Retinal fundus photograph, 45° field of view
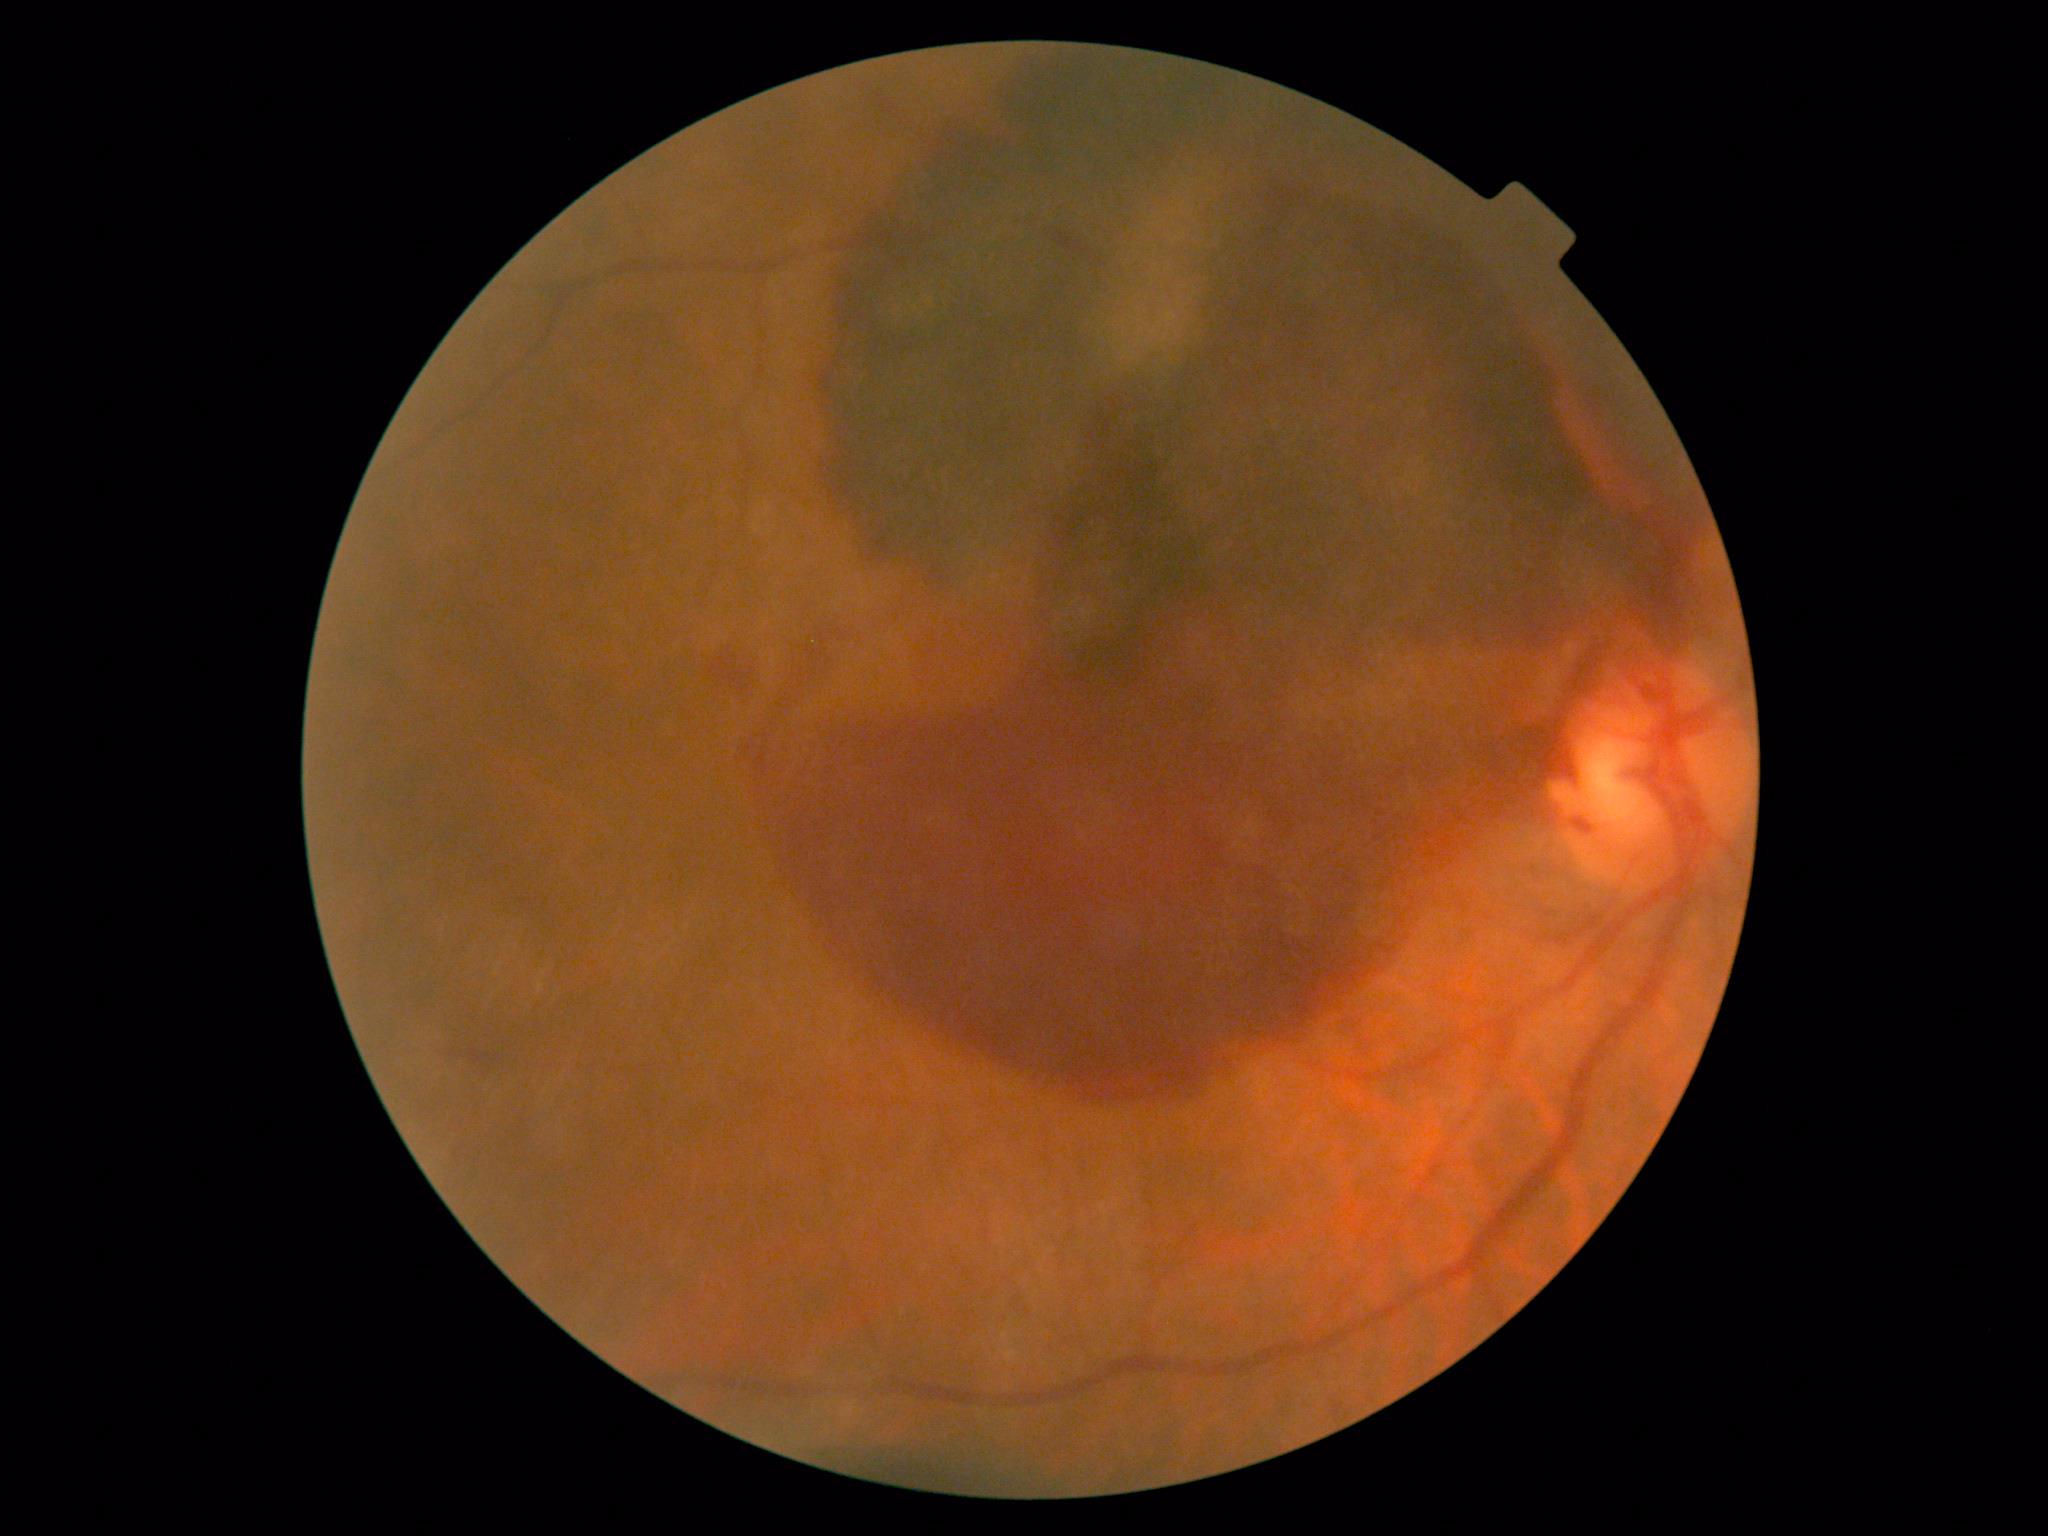 DR severity = grade 4 (PDR); DR class = proliferative diabetic retinopathy.